Color fundus photograph, image size 1380x1382
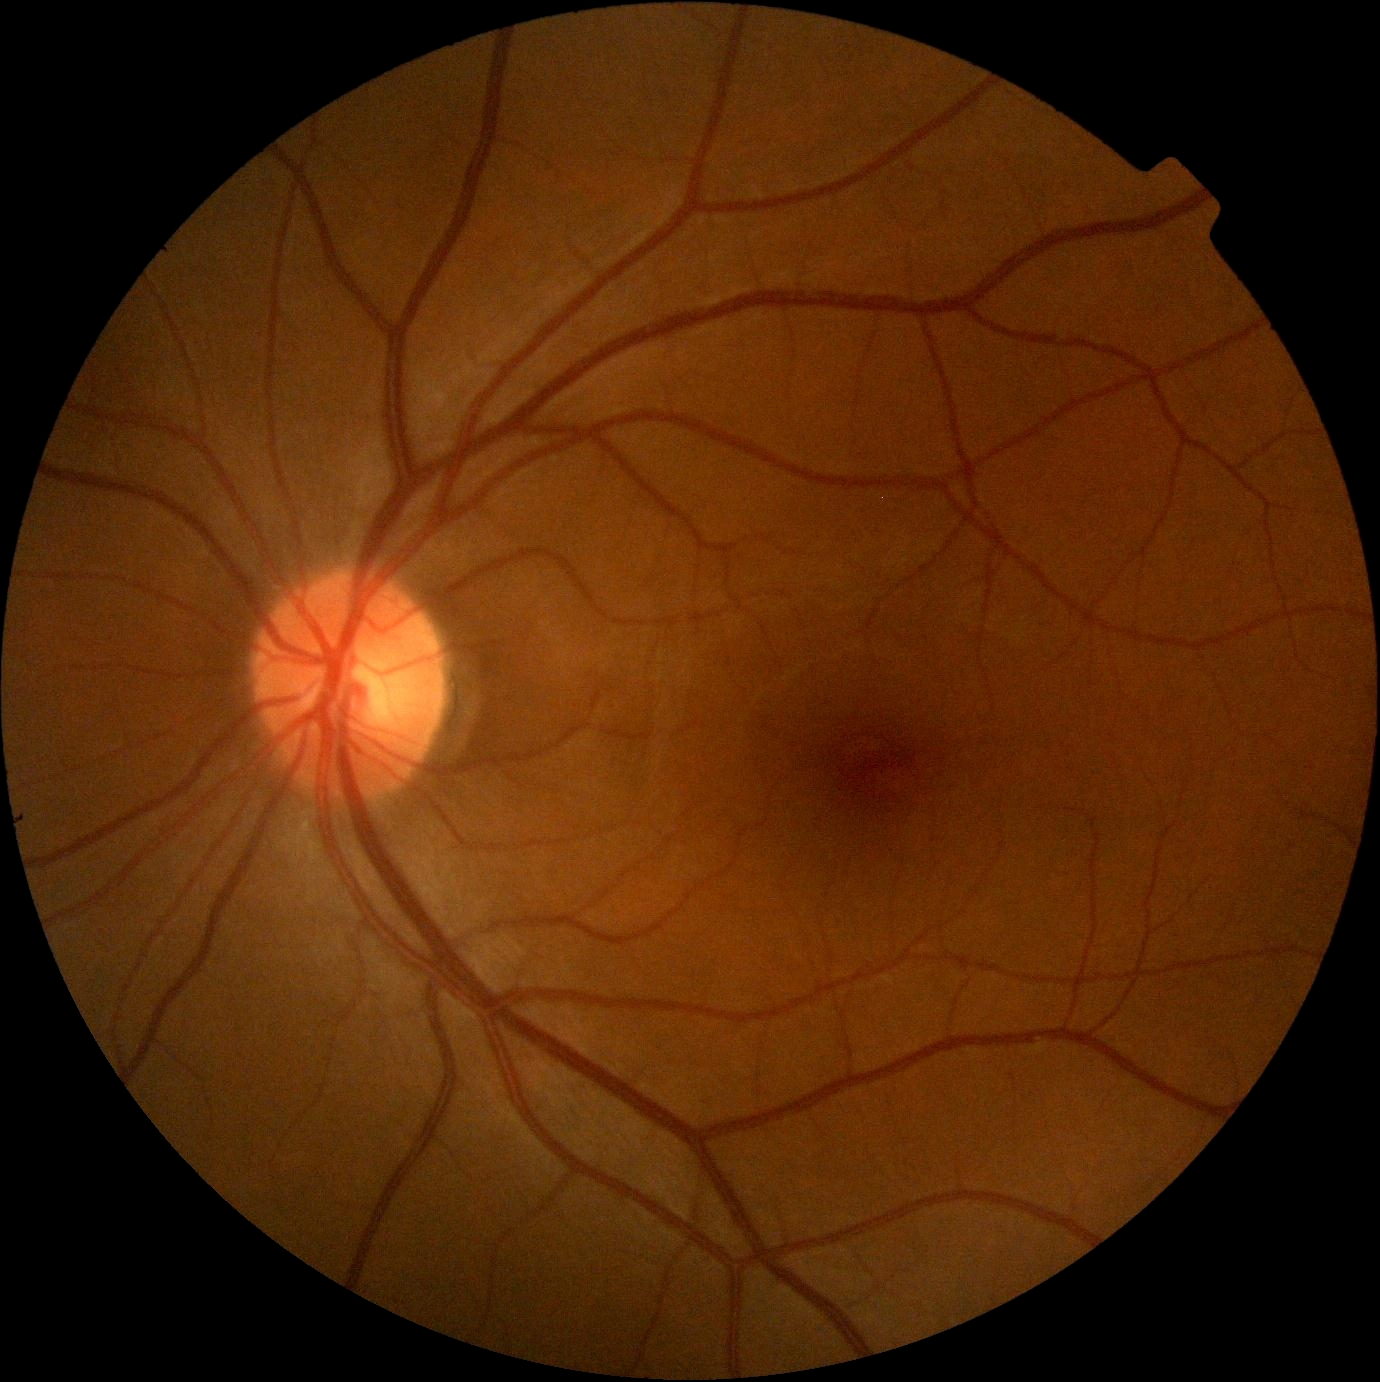
DR severity: grade 0, DR impression: no DR findings.